2212 by 1659 pixels, portable fundus camera image:
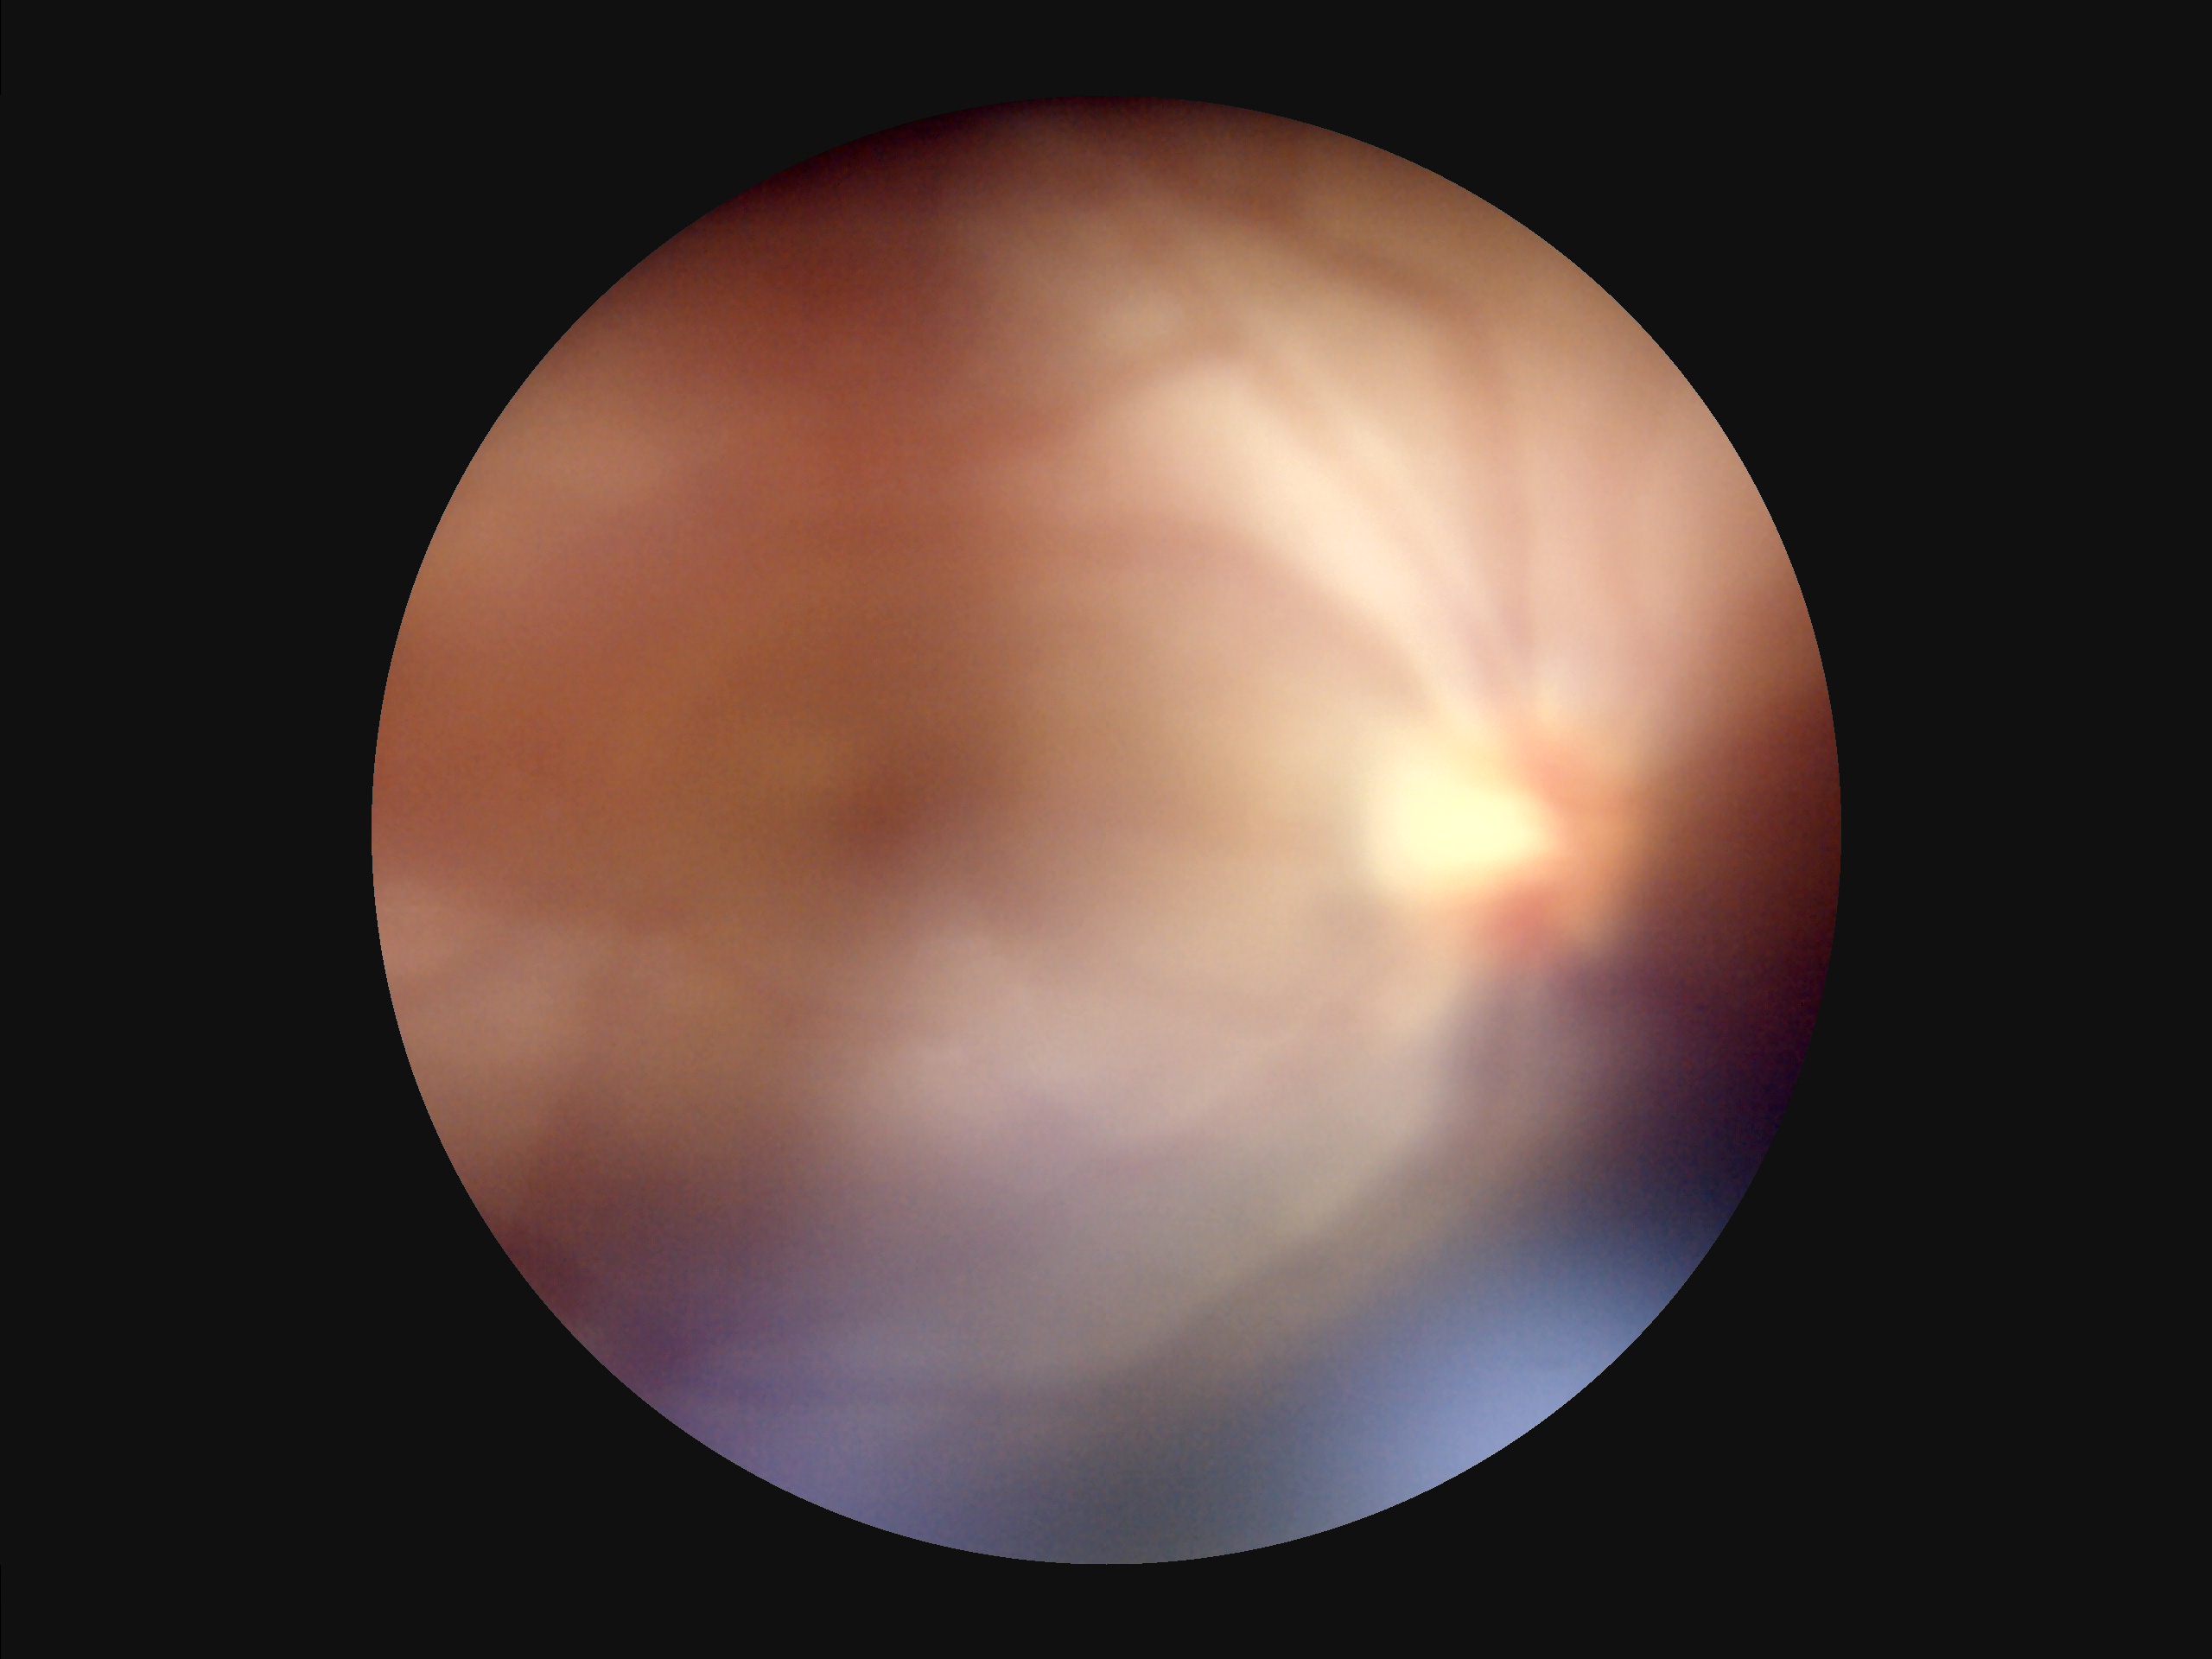 Focus = noticeable blur in the optic disc, vessels, or background | Contrast = poor dynamic range | Illumination/color = over- or under-exposed | Overall = inadequate for clinical interpretation.